DR severity per modified Davis staging
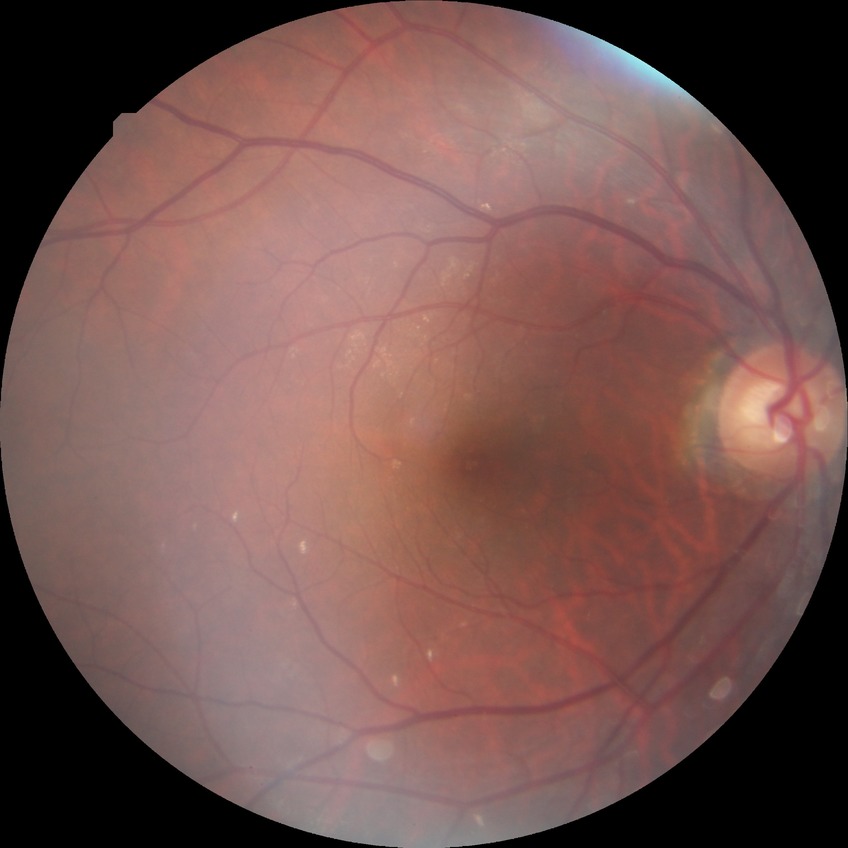 Diabetic retinopathy (DR) is no diabetic retinopathy (NDR).